Image size 2048x1536. 45-degree field of view
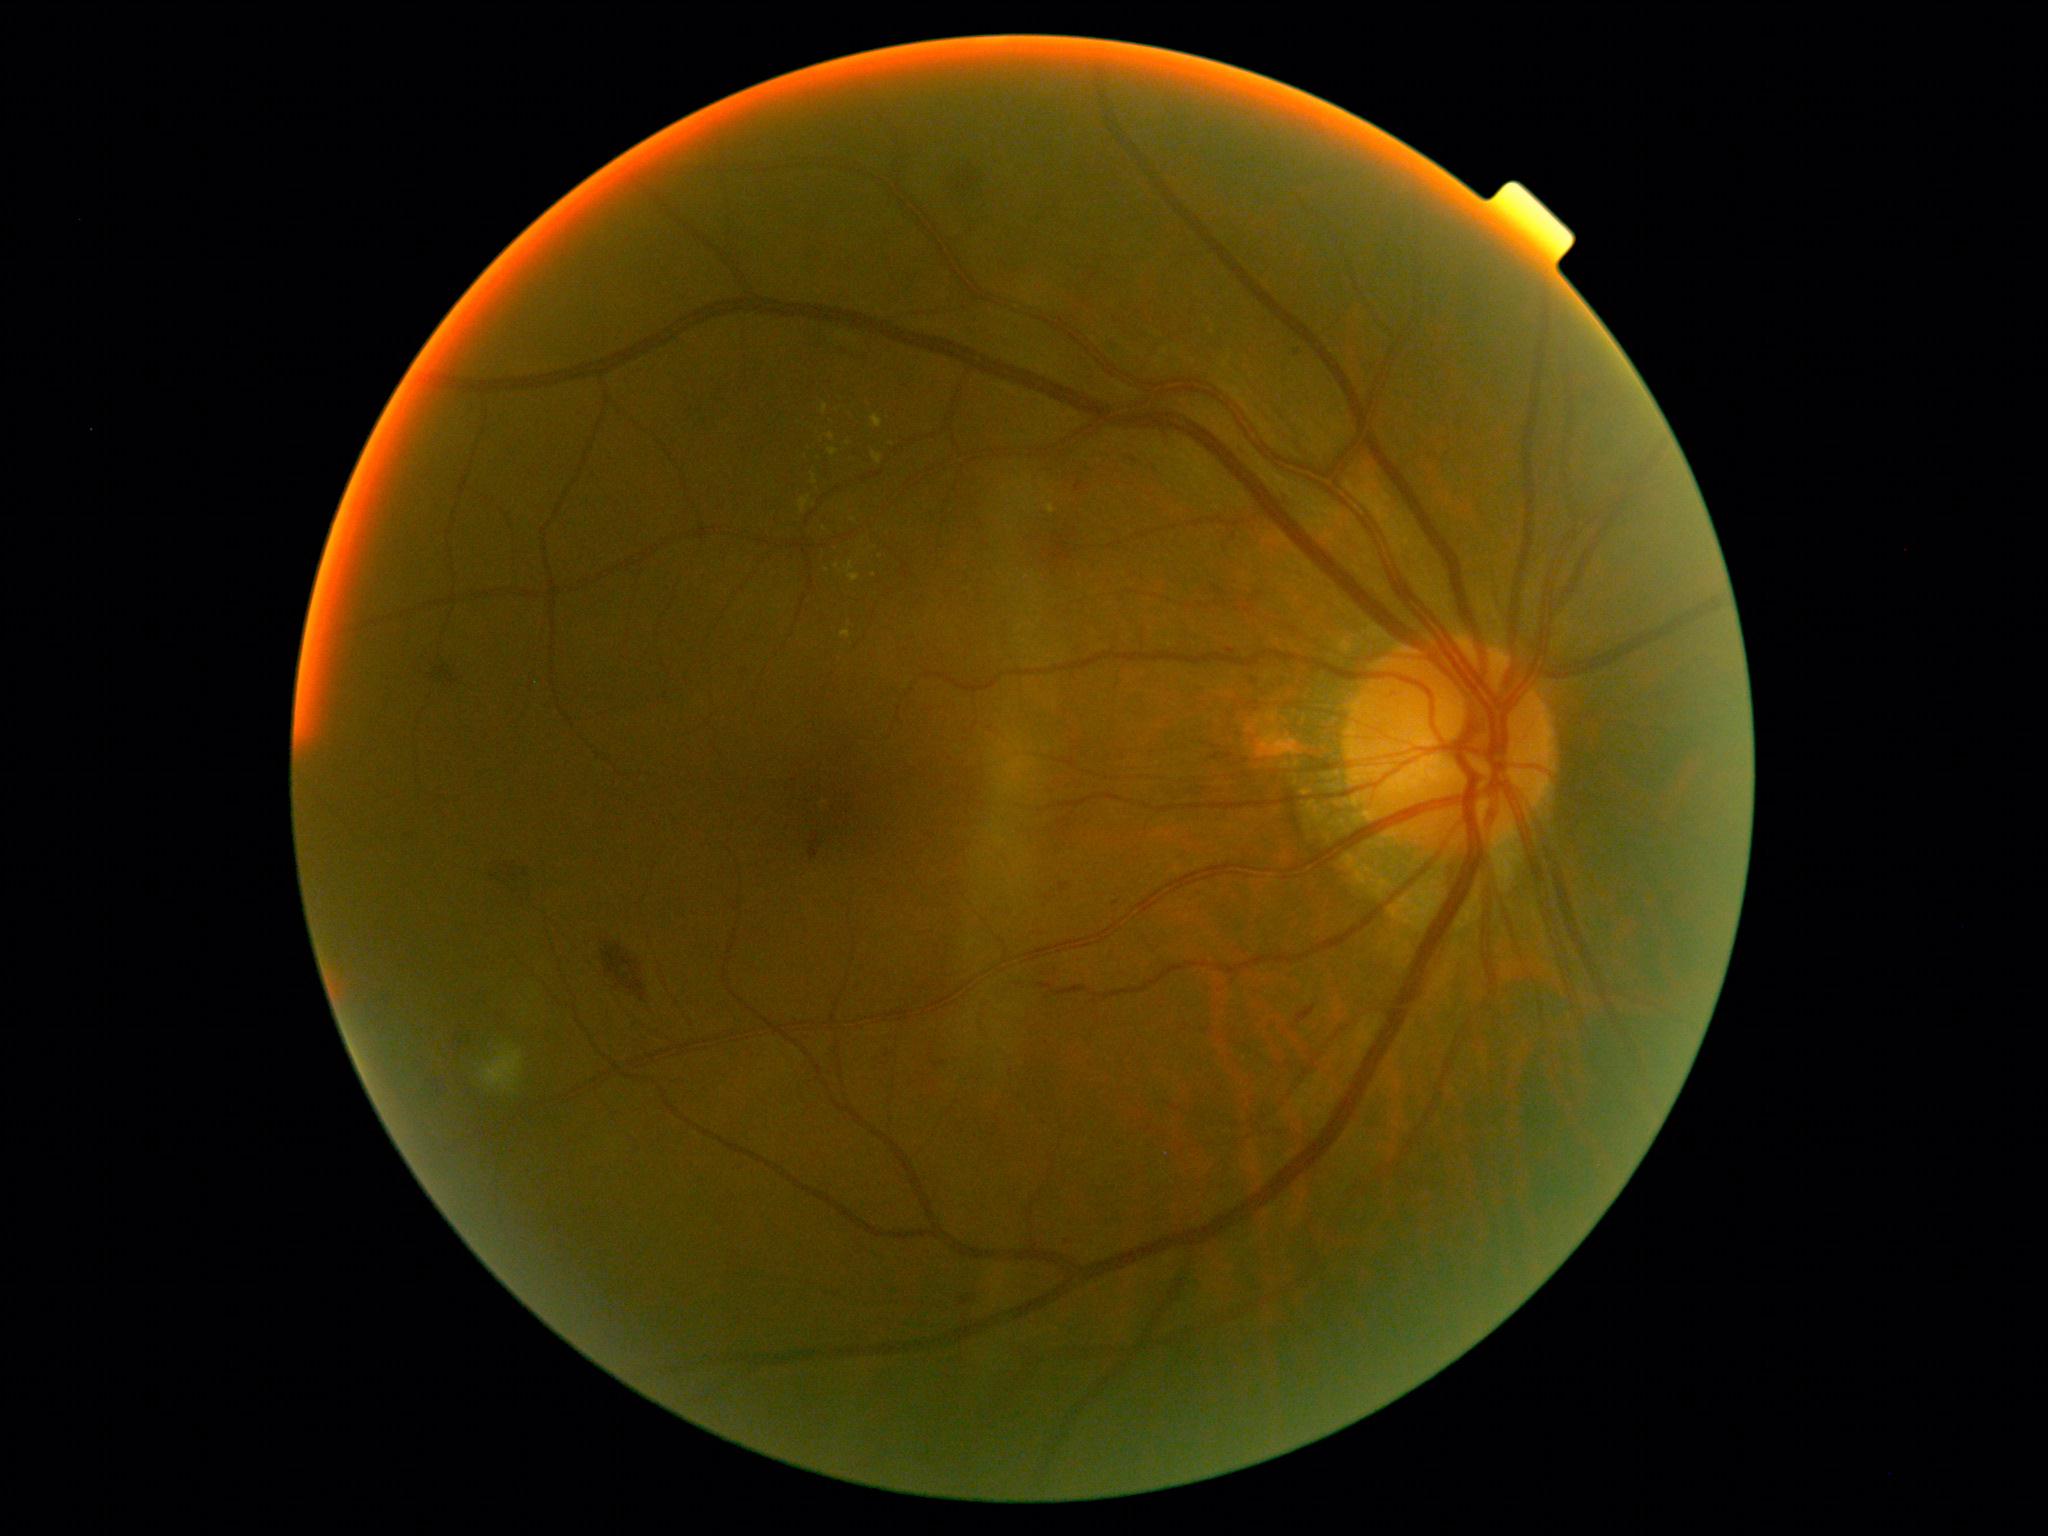

Diabetic retinopathy (DR) is grade 2 (moderate NPDR)
Selected lesions:
hemorrhages (HEs): [left=950, top=161, right=993, bottom=213] | [left=457, top=1030, right=473, bottom=1053] | [left=1045, top=522, right=1084, bottom=570] | [left=491, top=855, right=536, bottom=898] | [left=444, top=659, right=463, bottom=687] | [left=431, top=1074, right=445, bottom=1097] | [left=599, top=943, right=652, bottom=1001]
hard exudates (EXs) (more not shown): [left=873, top=452, right=883, bottom=465] | [left=813, top=474, right=818, bottom=485] | [left=871, top=415, right=883, bottom=428] | [left=823, top=405, right=828, bottom=415] | [left=1048, top=505, right=1055, bottom=514] | [left=800, top=497, right=811, bottom=512] | [left=844, top=561, right=860, bottom=583] | [left=841, top=631, right=851, bottom=639] | [left=828, top=448, right=838, bottom=457] | [left=828, top=434, right=836, bottom=441]
Small EXs approximately at pt(827, 570) | pt(848, 443) | pt(874, 575) | pt(854, 520) | pt(837, 566) | pt(825, 529)
microaneurysms (MAs): [left=1296, top=1006, right=1316, bottom=1024] | [left=1295, top=350, right=1300, bottom=358] | [left=1045, top=895, right=1054, bottom=900] | [left=933, top=1060, right=946, bottom=1069] | [left=808, top=832, right=823, bottom=861] | [left=960, top=1297, right=970, bottom=1307] | [left=1227, top=649, right=1236, bottom=656] | [left=1059, top=882, right=1071, bottom=894] | [left=1075, top=481, right=1084, bottom=492]
Small MAs approximately at pt(888, 1055) | pt(957, 885) | pt(1116, 903) | pt(1294, 1027)
soft exudates (SEs): [left=481, top=1044, right=524, bottom=1093]
Small SEs approximately at pt(488, 1091)